Color fundus image; 45° field of view; graded on the modified Davis scale:
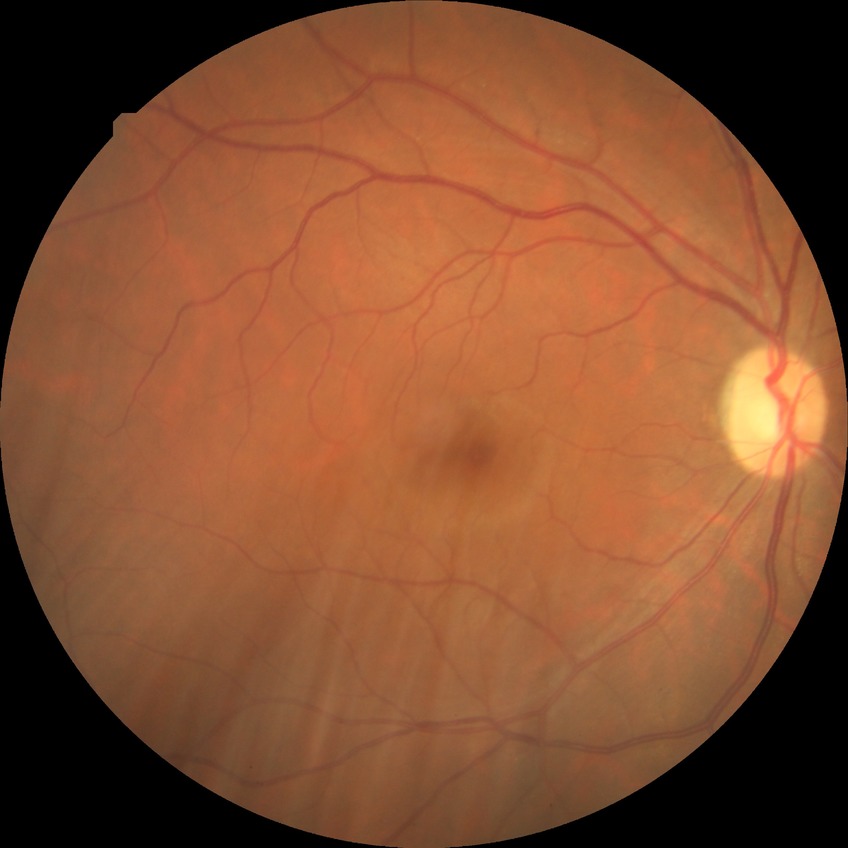
Diabetic retinopathy (DR): NDR (no diabetic retinopathy).